No pharmacologic dilation. FOV: 45 degrees
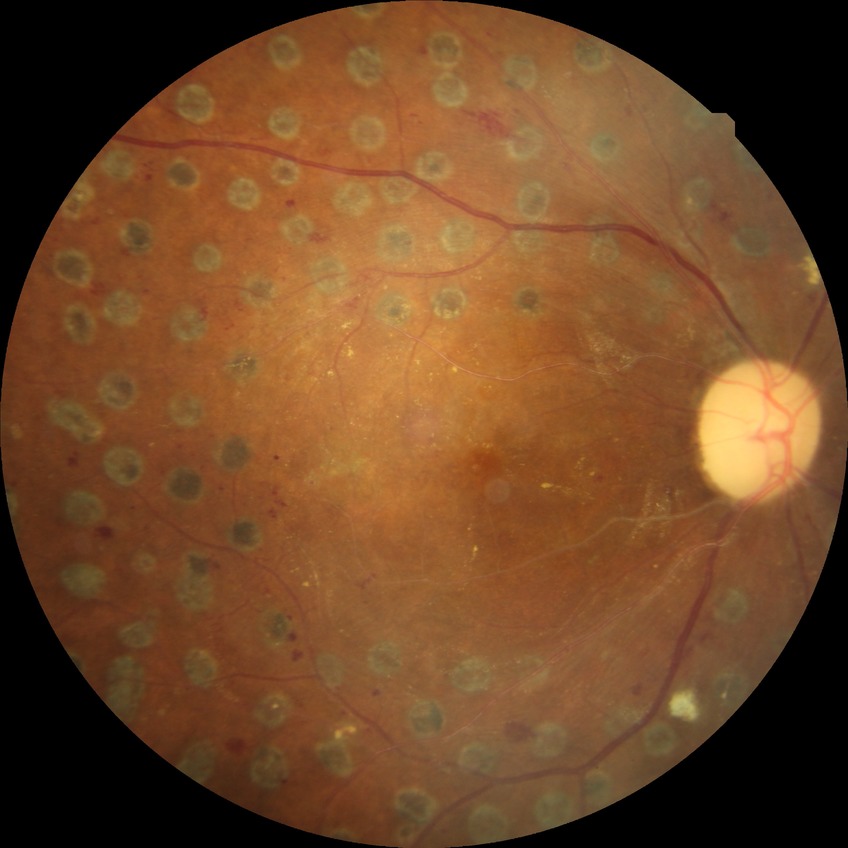
  davis_grade: proliferative diabetic retinopathy